Optic disc photograph · 310 x 310 pixels.
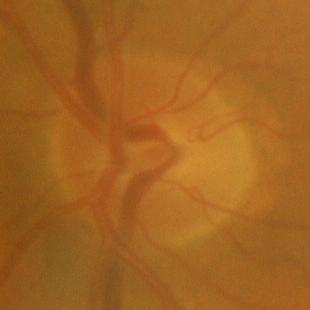 No glaucomatous findings.